2212x1659. Color fundus photograph from a handheld portable camera — 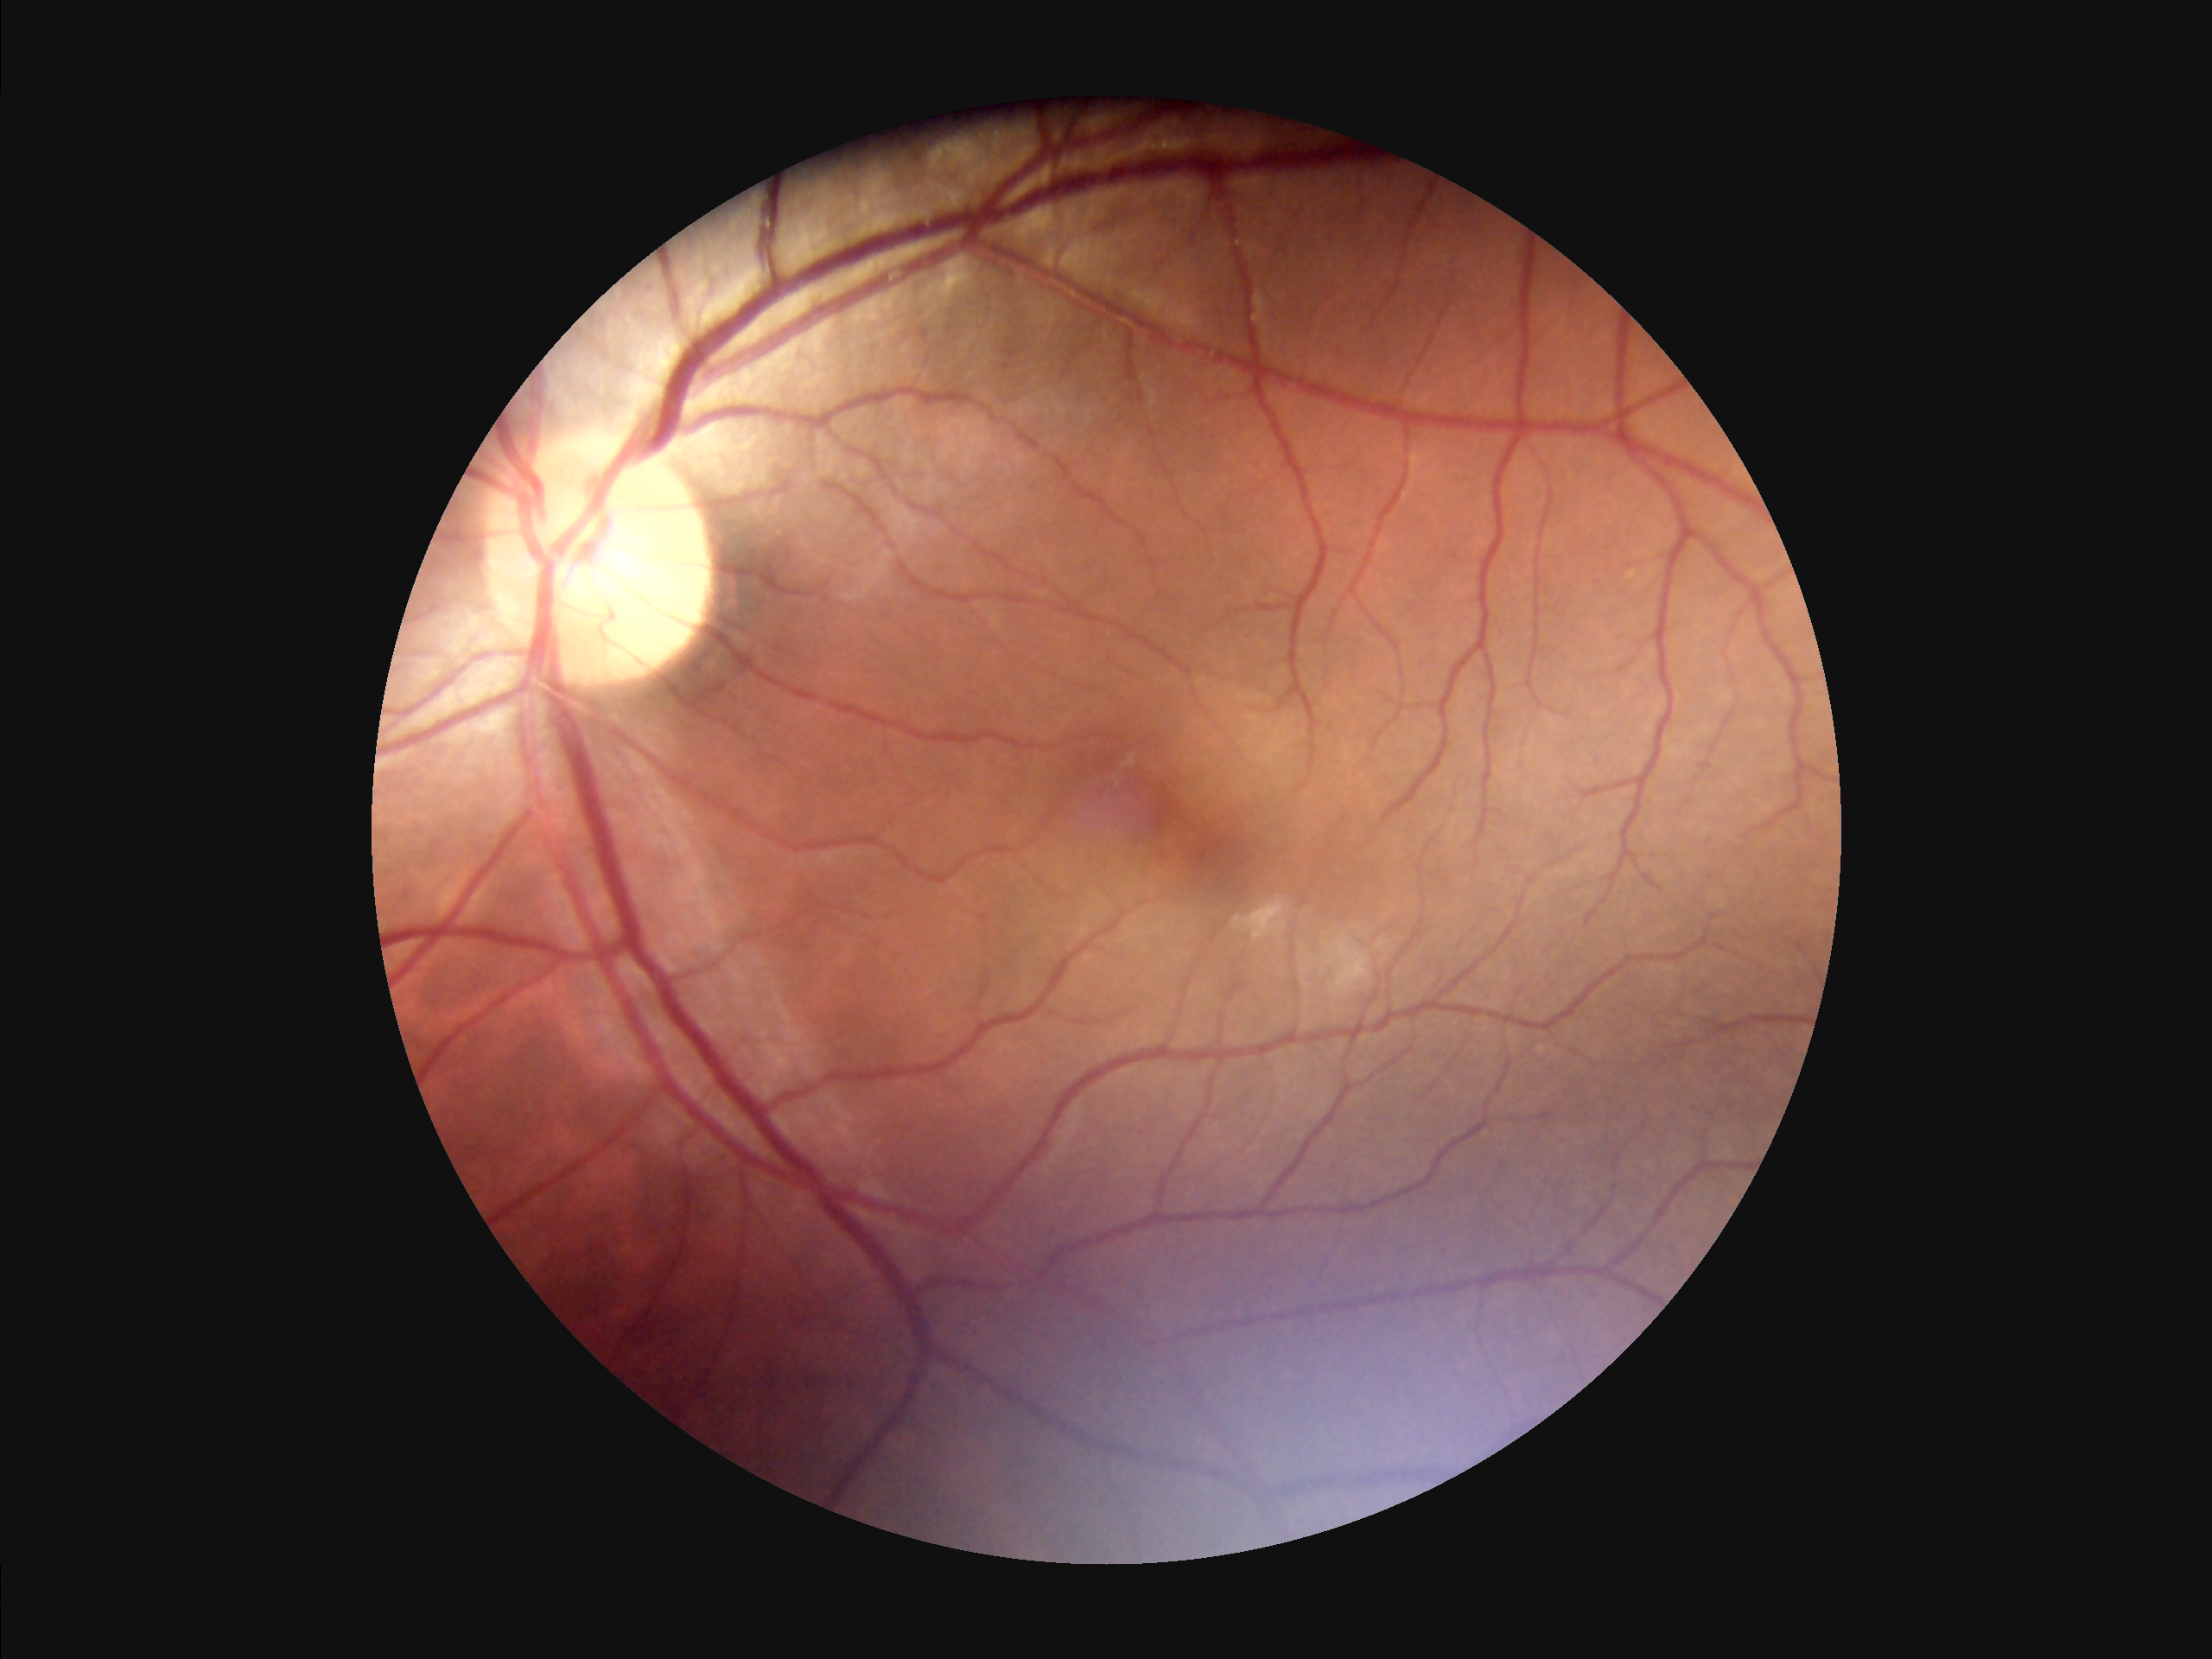

Illumination: suboptimal
Focus: sharp
Overall image quality: adequate